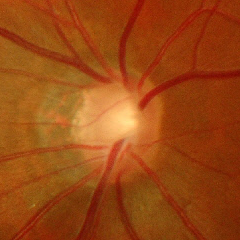

Glaucoma status: advanced glaucoma.